FOV: 45 degrees · retinal fundus photograph
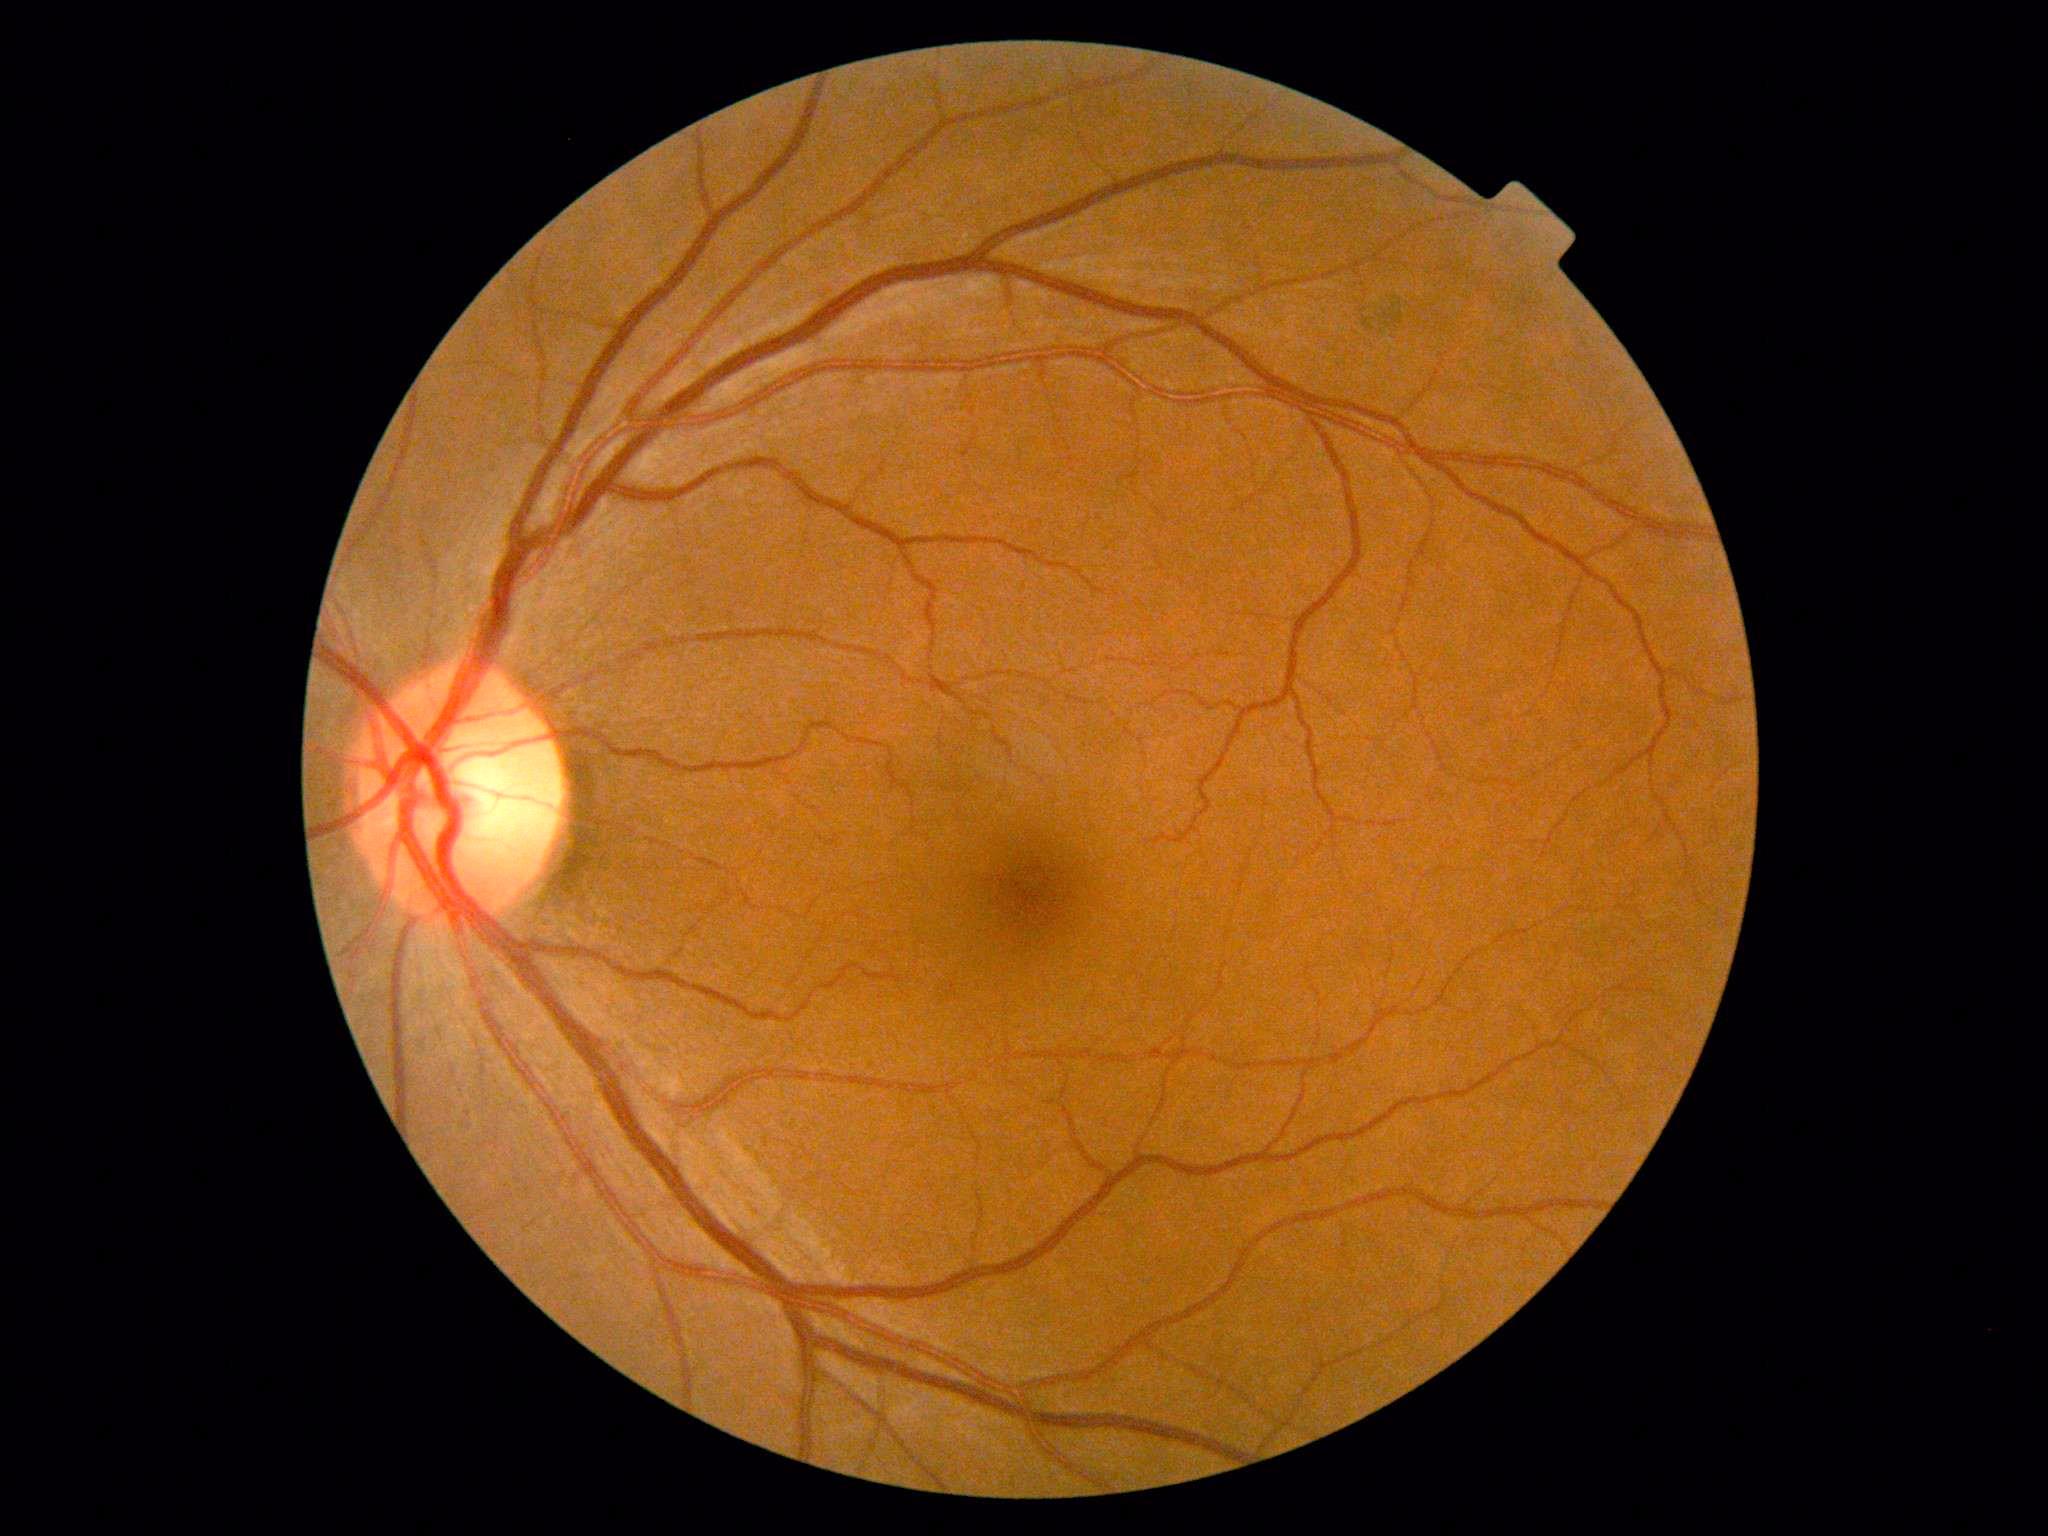
Retinopathy is 0/4.